Posterior pole photograph. 45-degree field of view. Image size 848x848
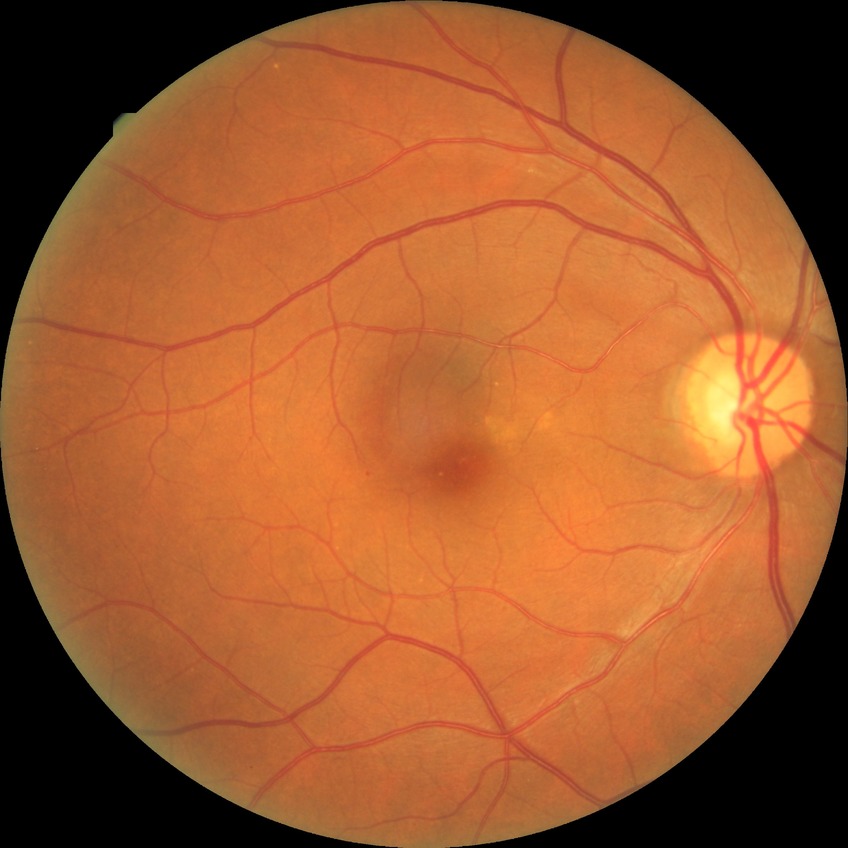

{
  "davis_grade": "NDR (no diabetic retinopathy)"
}